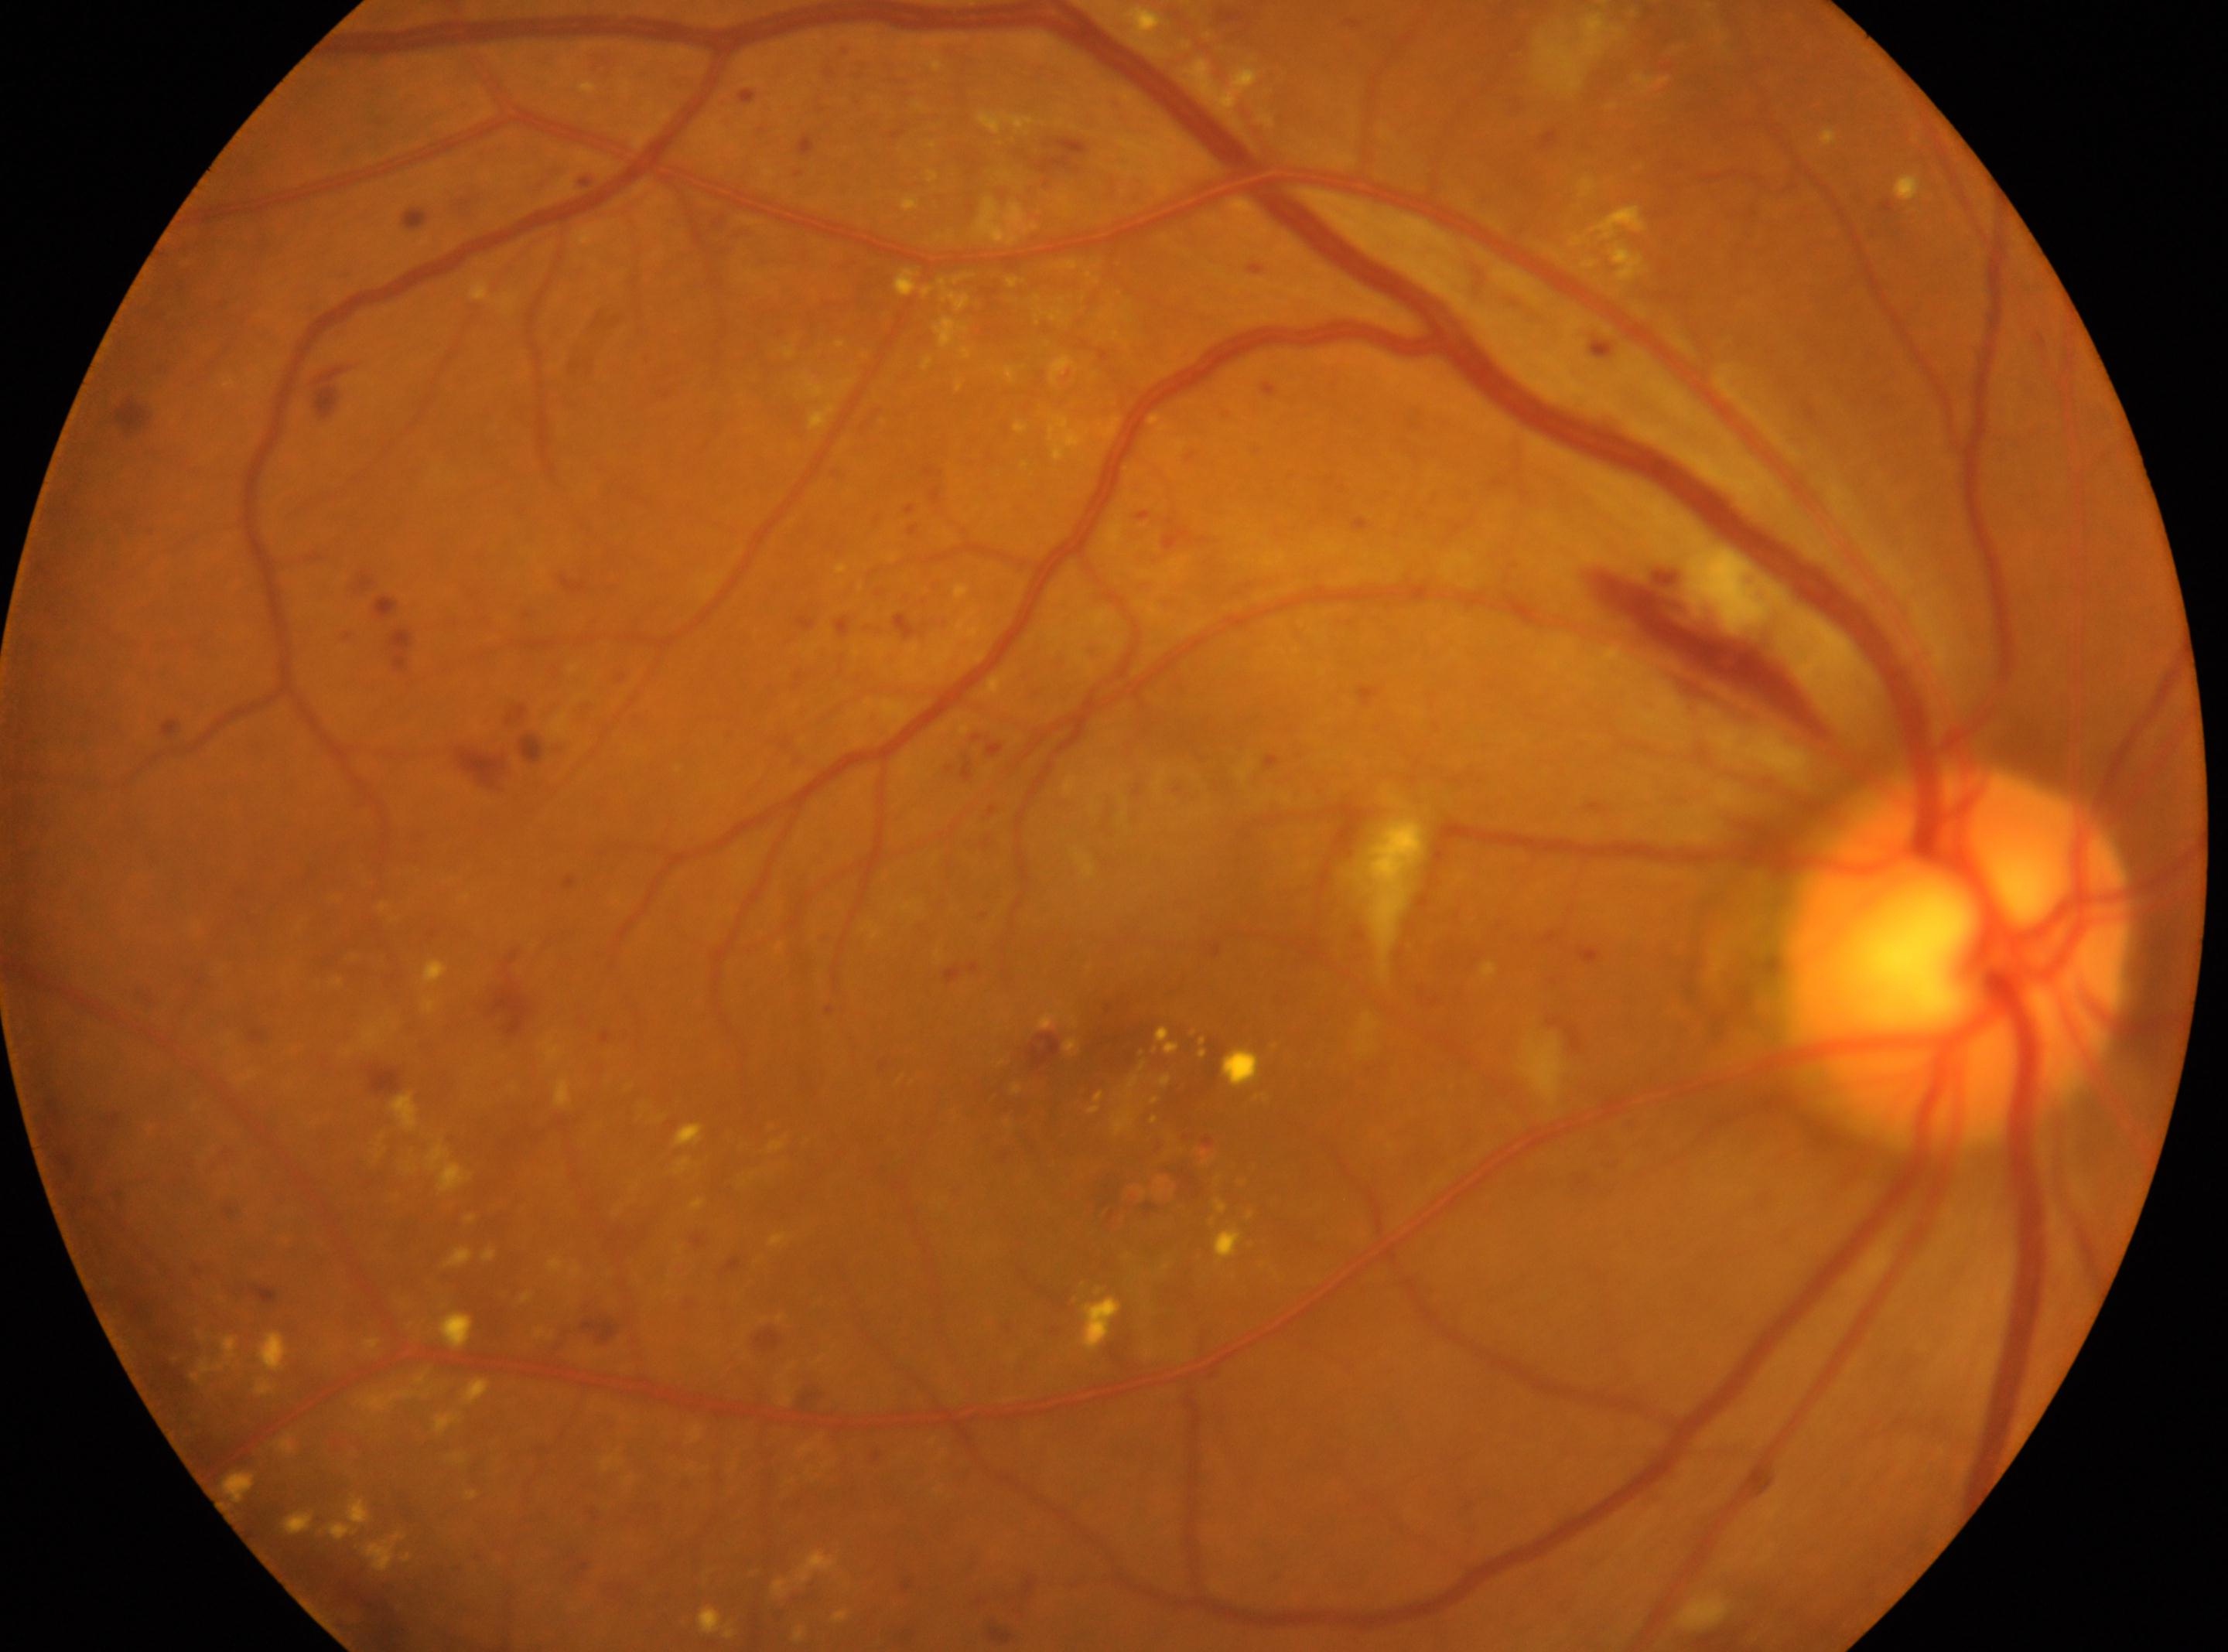

Annotations:
* optic disc: x=1957, y=957
* diabetic retinopathy (DR): 3/4
* laterality: right
* fovea: x=1109, y=1075